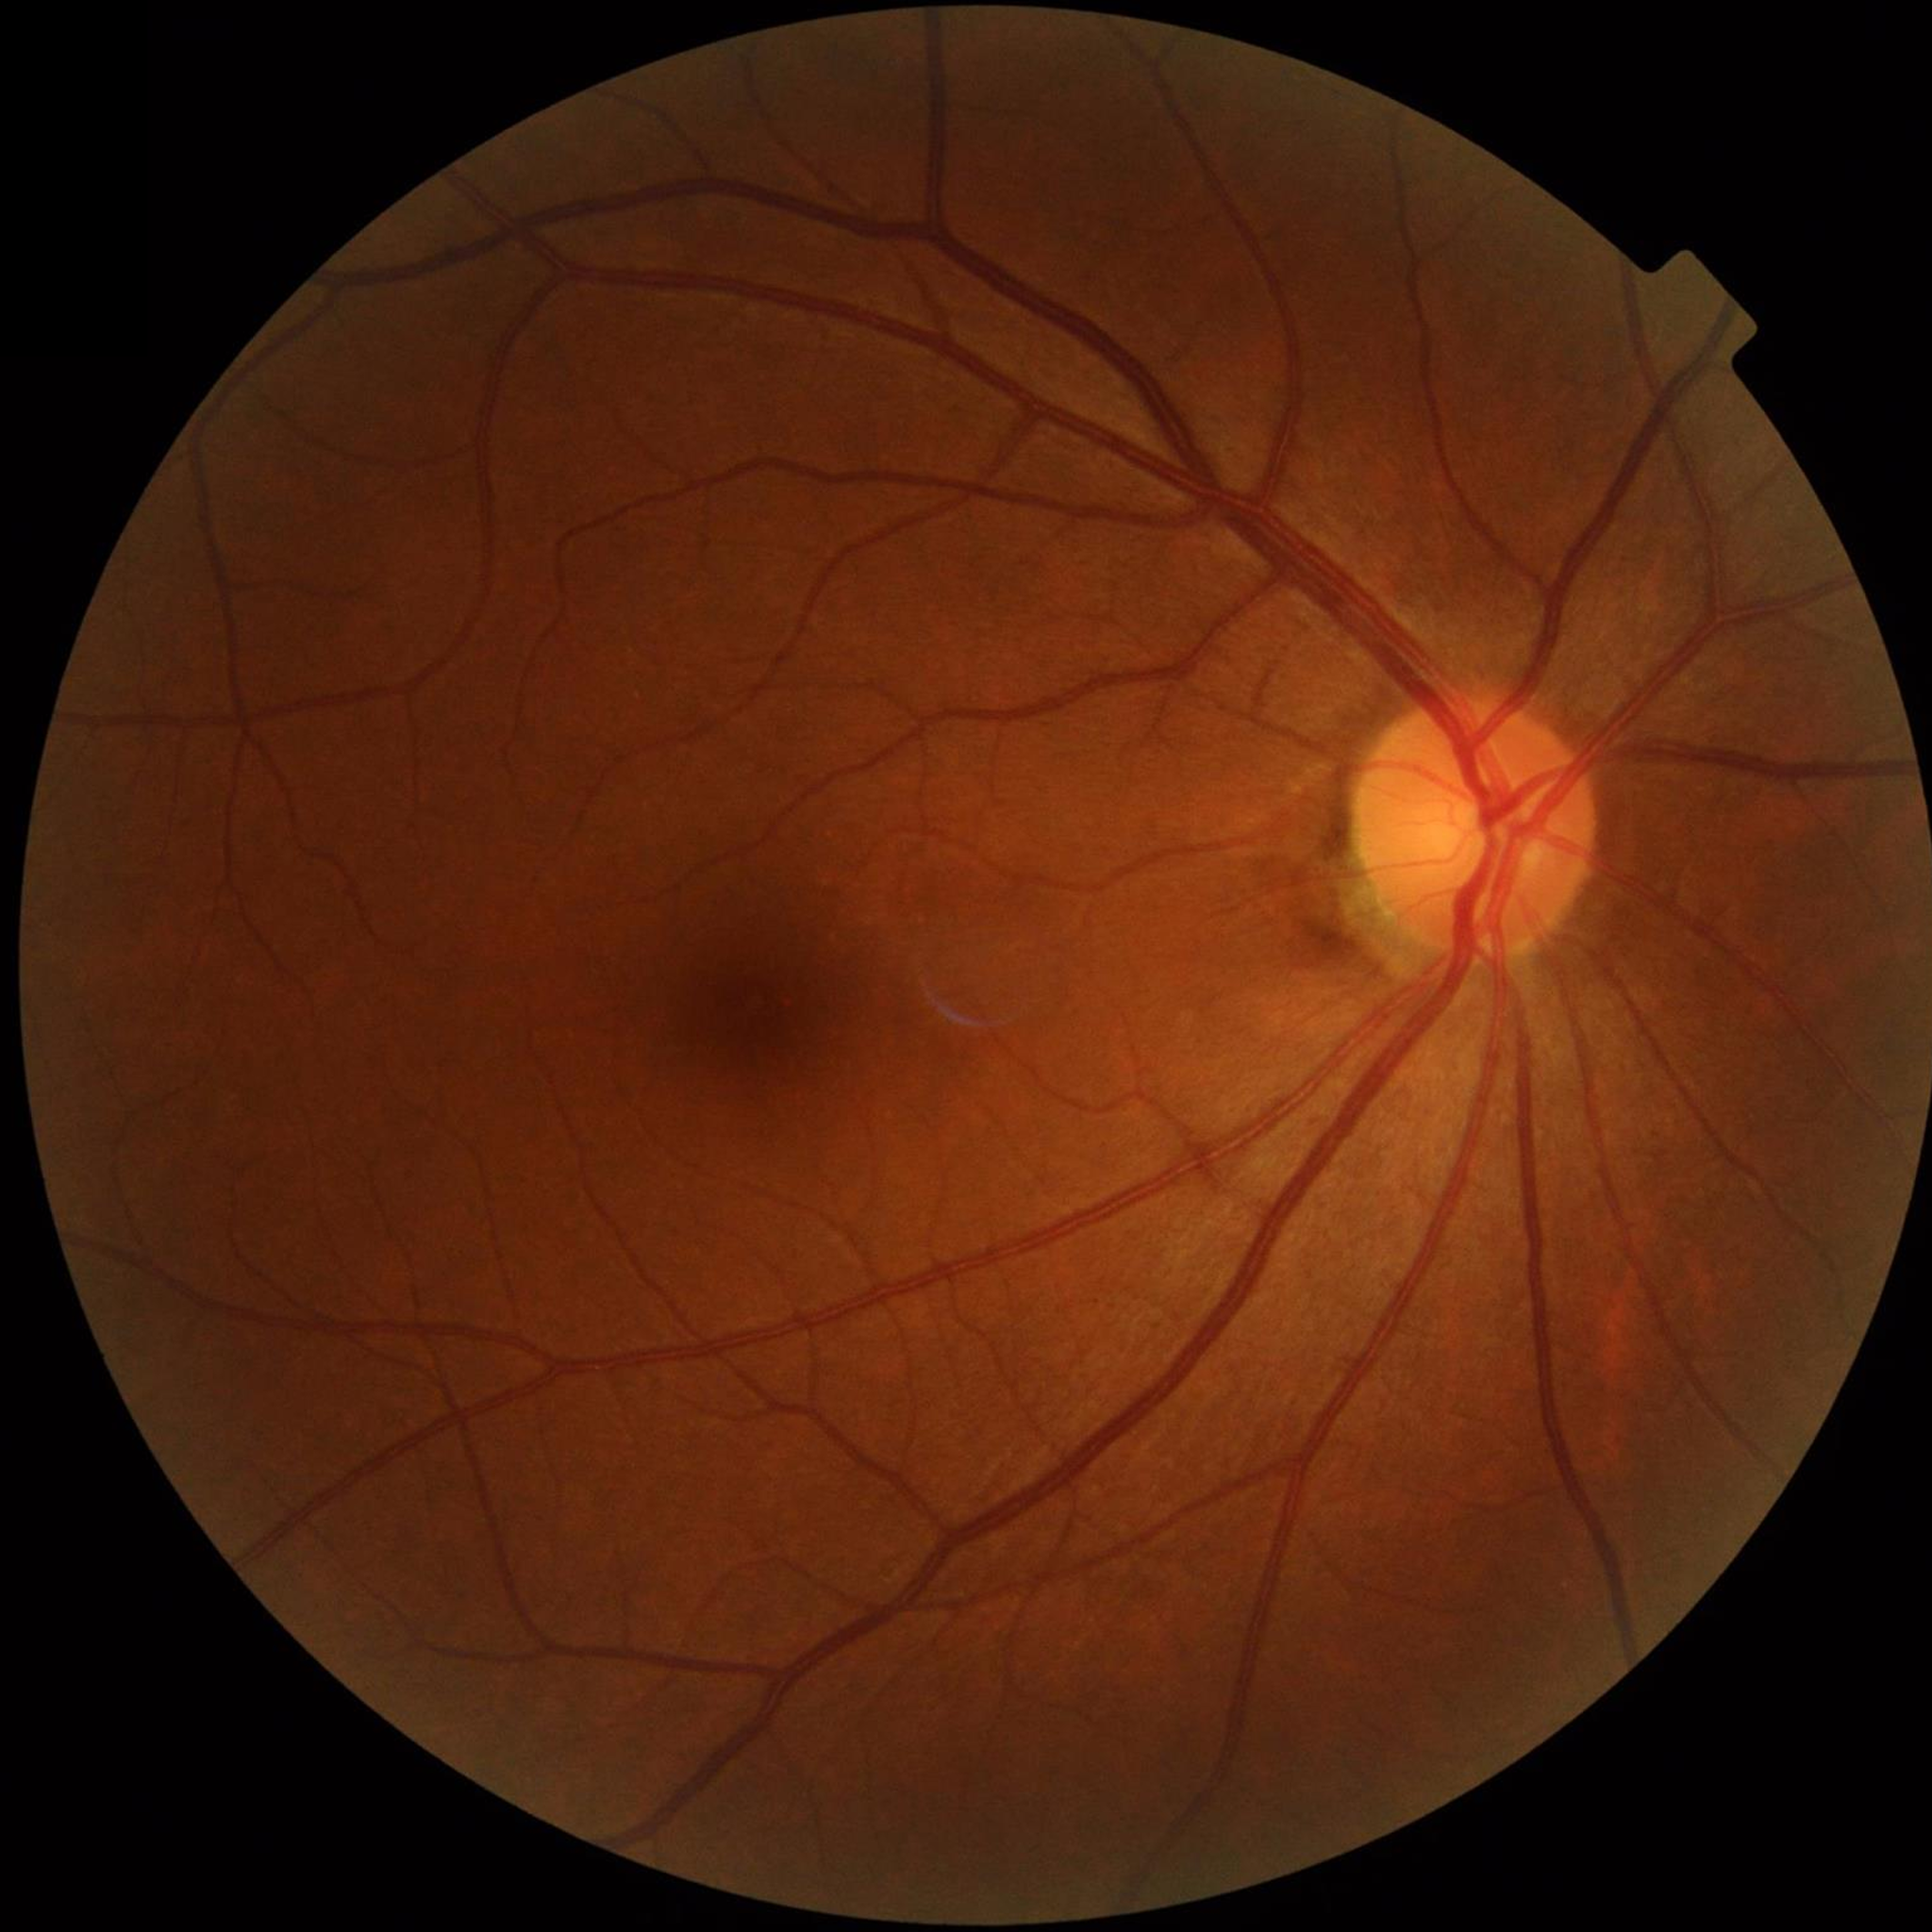
No findings of AMD, diabetic retinopathy, or glaucoma.